Without pupil dilation; FOV: 45 degrees; 848x848.
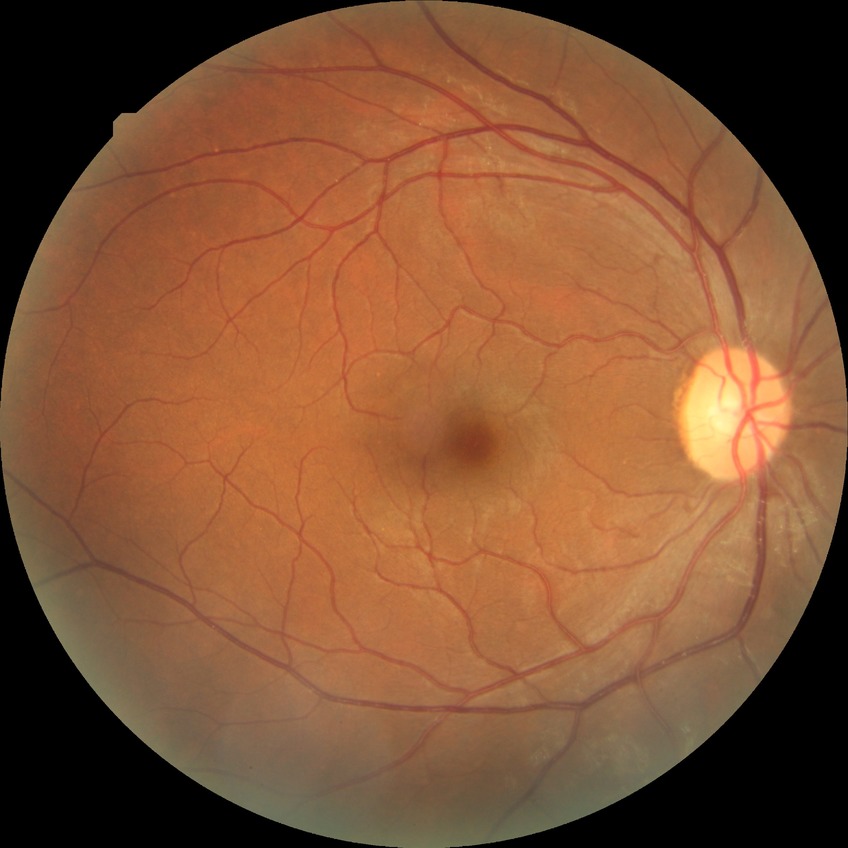

– modified Davis classification — no diabetic retinopathy